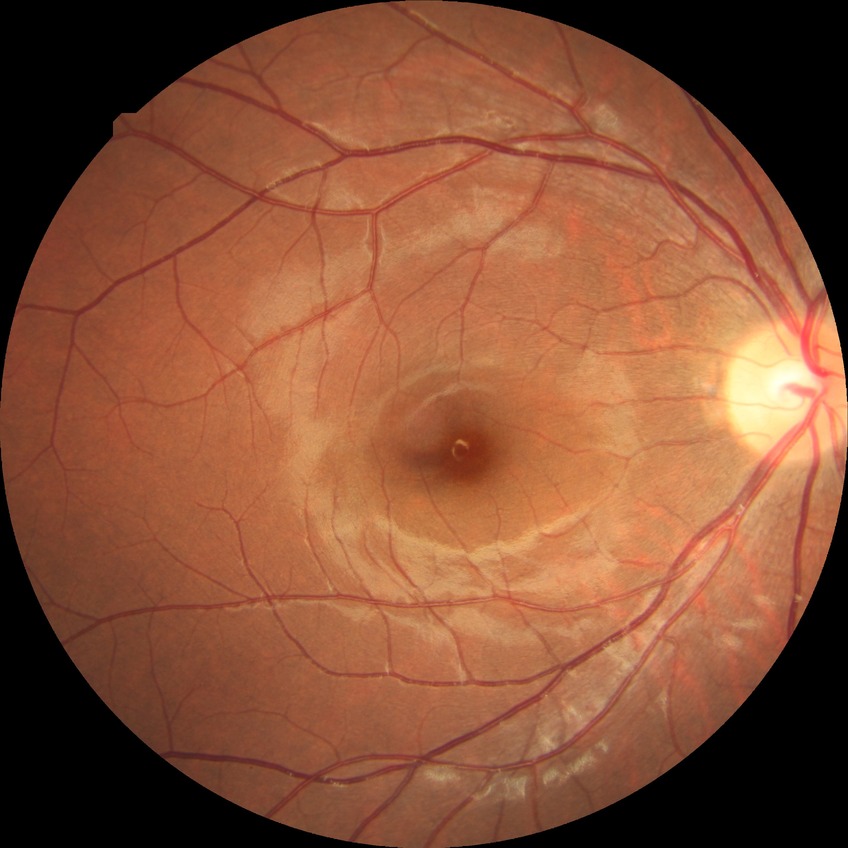

diabetic retinopathy grade: no diabetic retinopathy.